Graded on the modified Davis scale
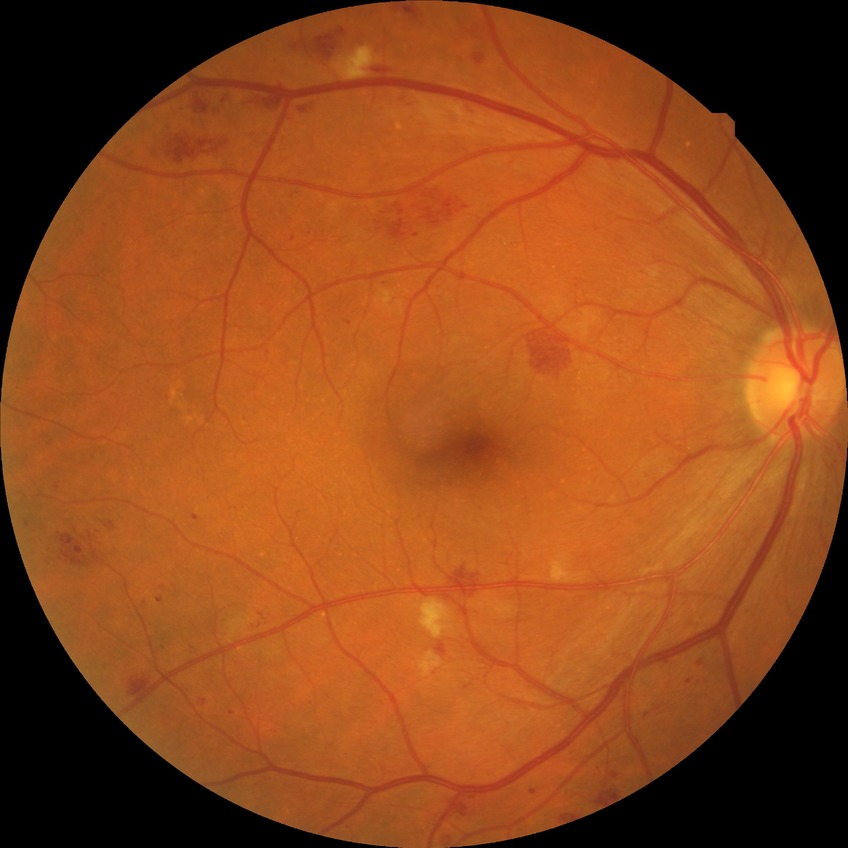 Diabetic retinopathy (DR) is pre-proliferative diabetic retinopathy (PPDR).